512x512: 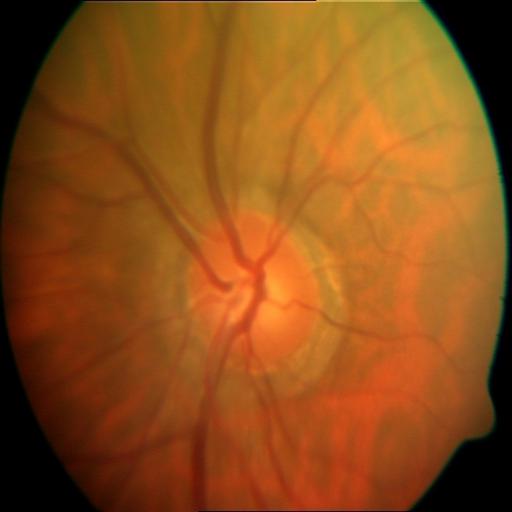

Abnormalities:
- myopia (MYA)